848x848; graded on the modified Davis scale
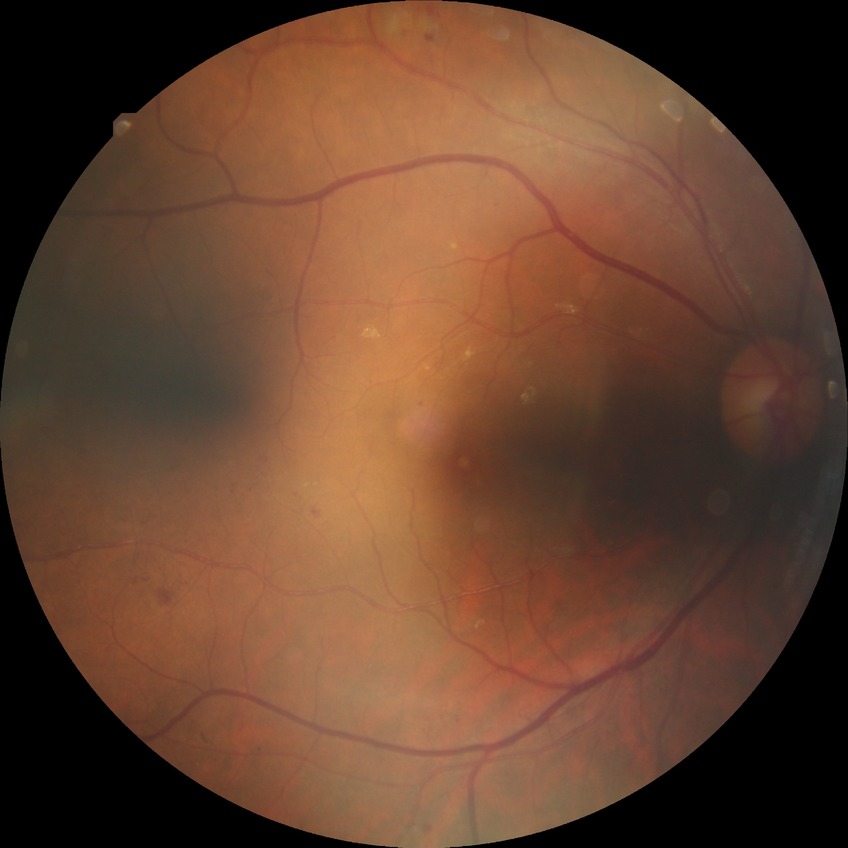

Diabetic retinopathy (DR) is simple diabetic retinopathy (SDR).